Davis DR grading
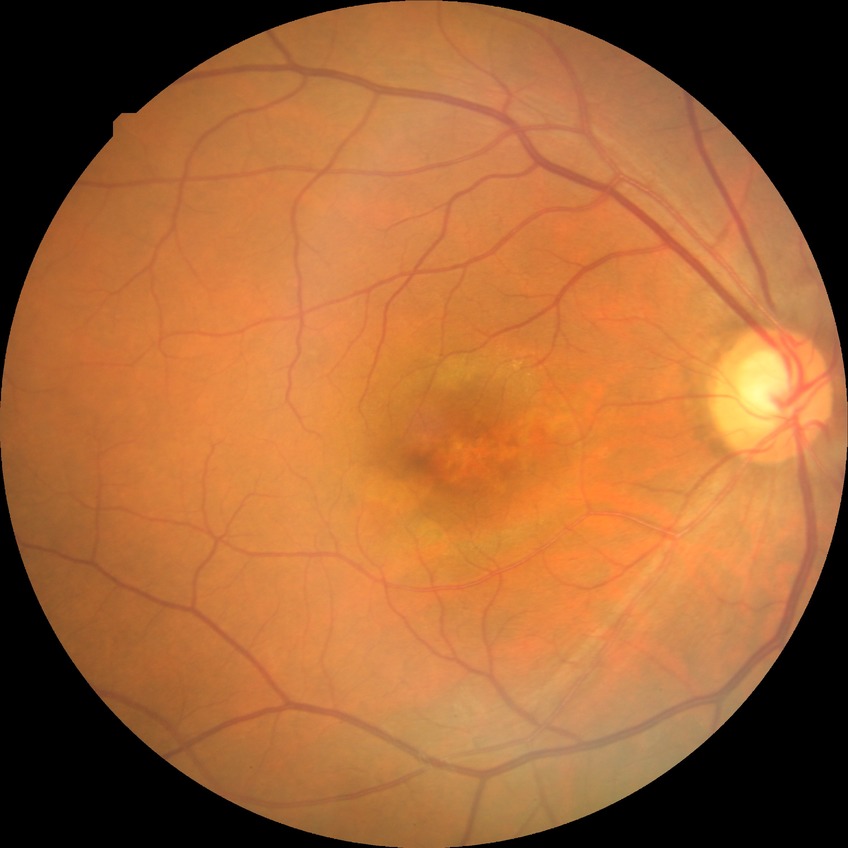 modified Davis grading: no diabetic retinopathy.